2352x1568. Color fundus photograph:
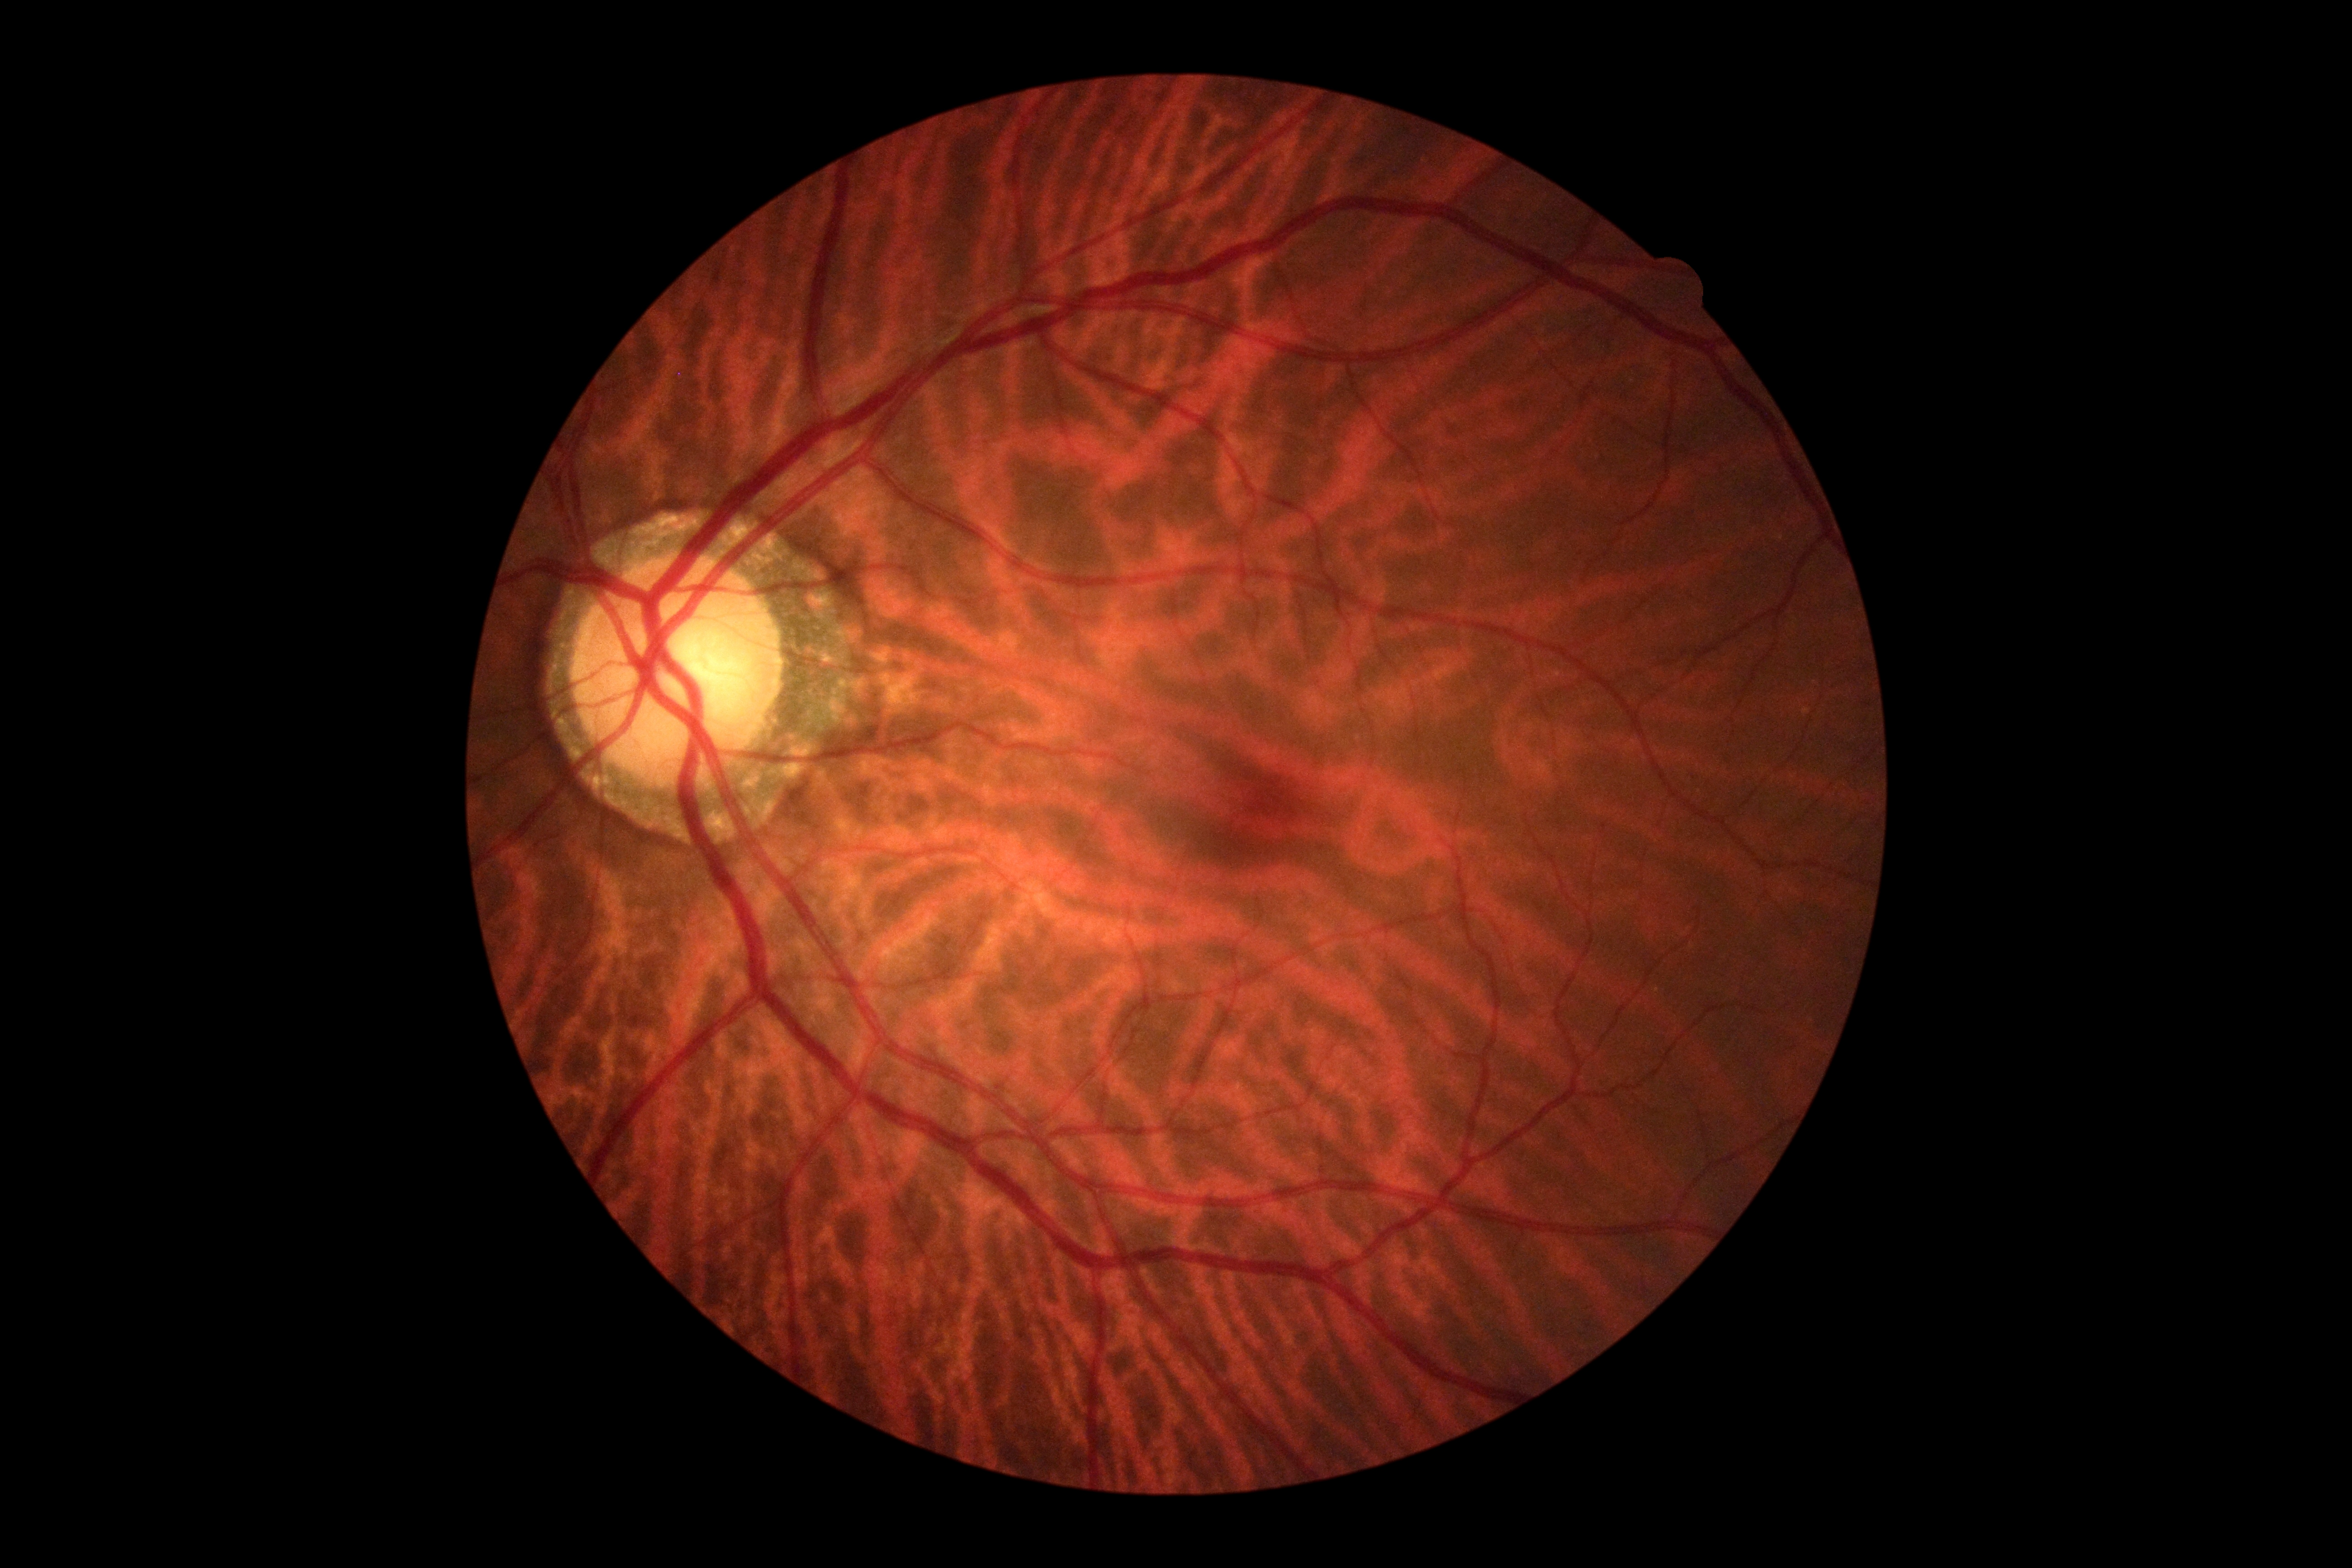 No apparent diabetic retinopathy.
DR severity: grade 0.